Color fundus photograph
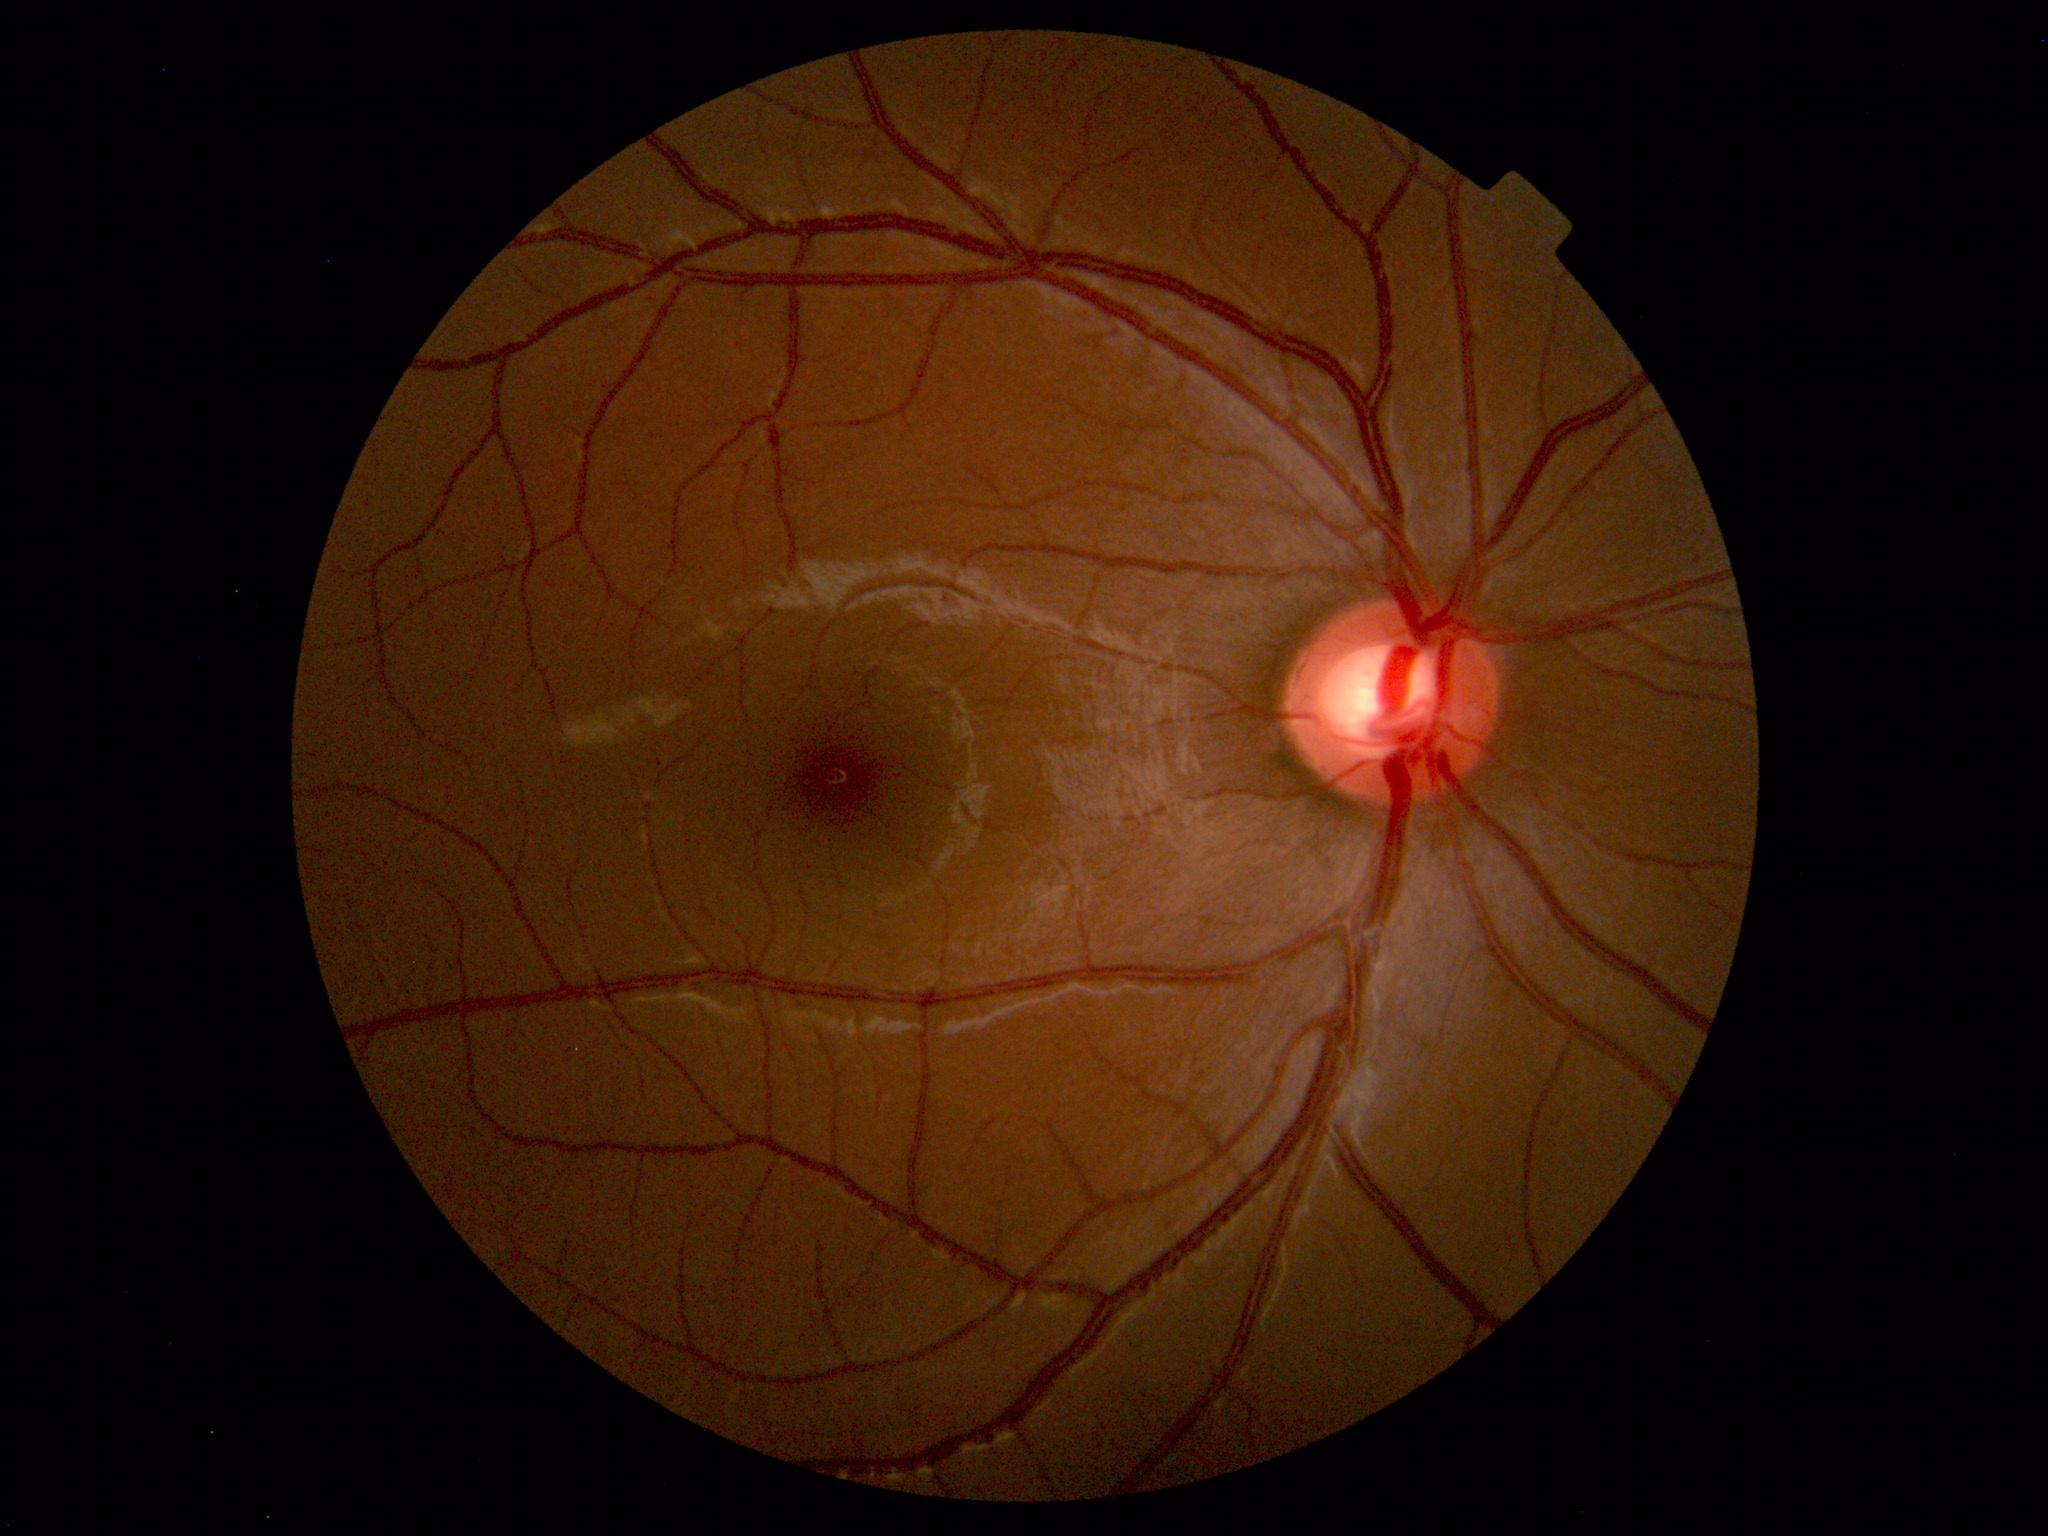 Within normal limits. No abnormalities identified.